130° field of view (Natus RetCam Envision); pediatric wide-field fundus photograph; 1440x1080 — 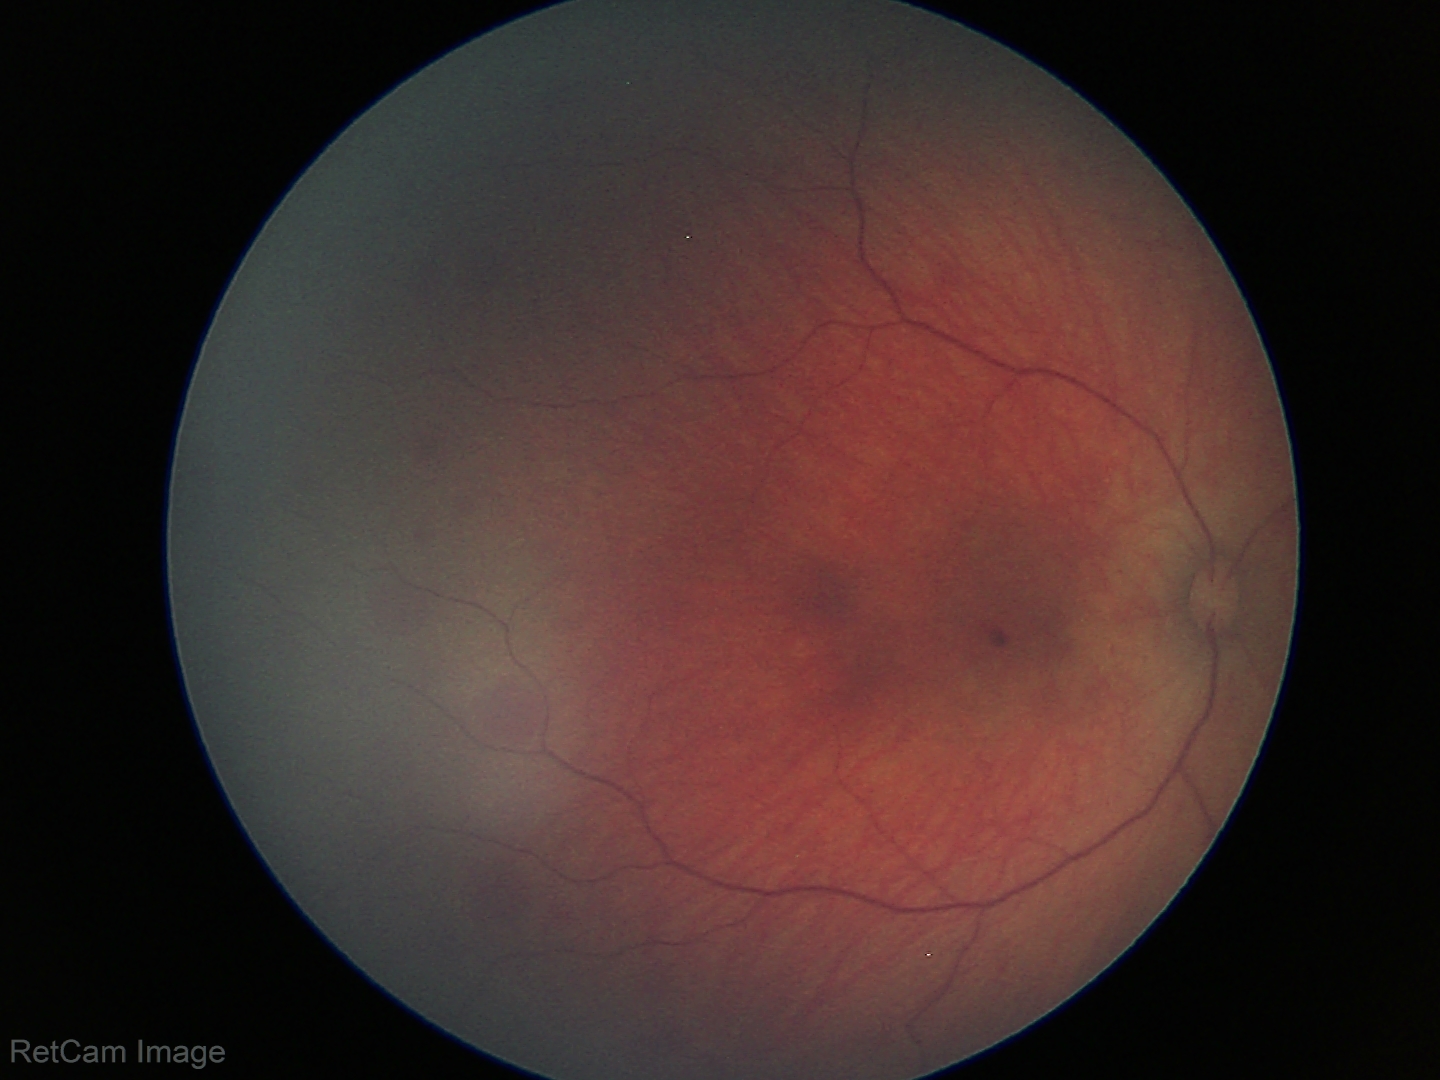

Screening series with retinal hemorrhages.